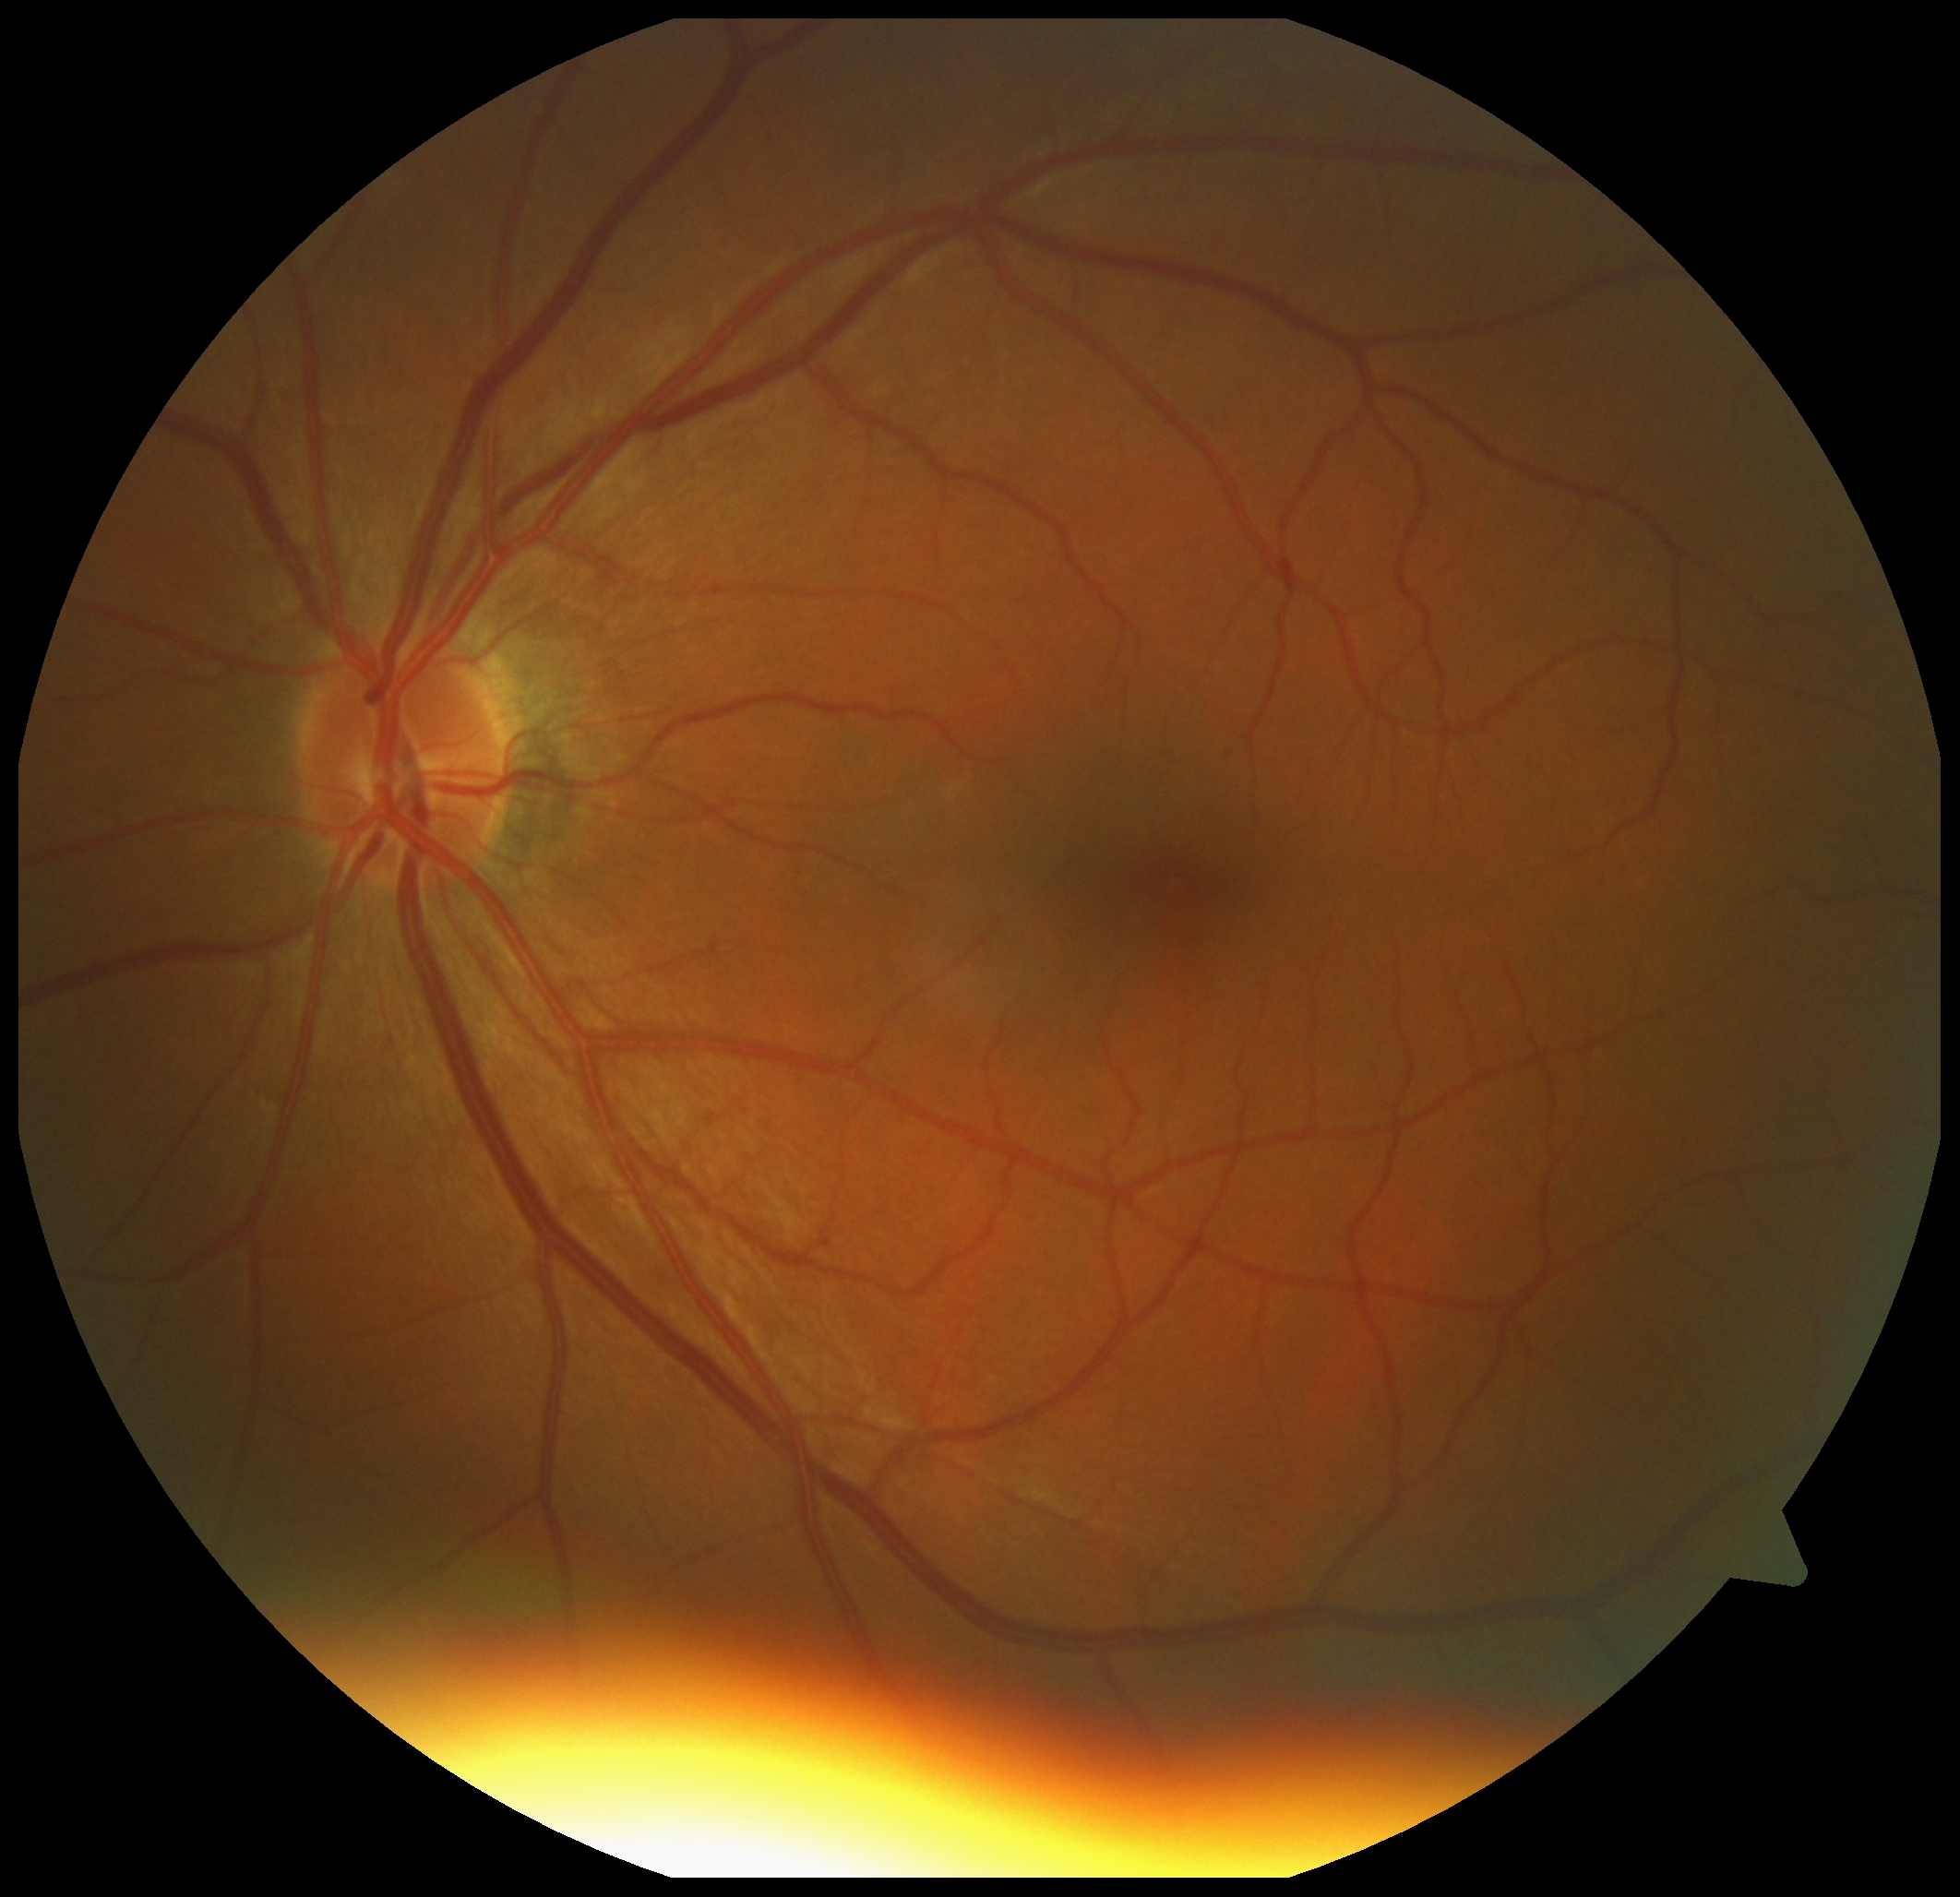 DR severity: grade 1 (mild NPDR).